Color fundus photograph, FOV: 45 degrees, 2212x1659:
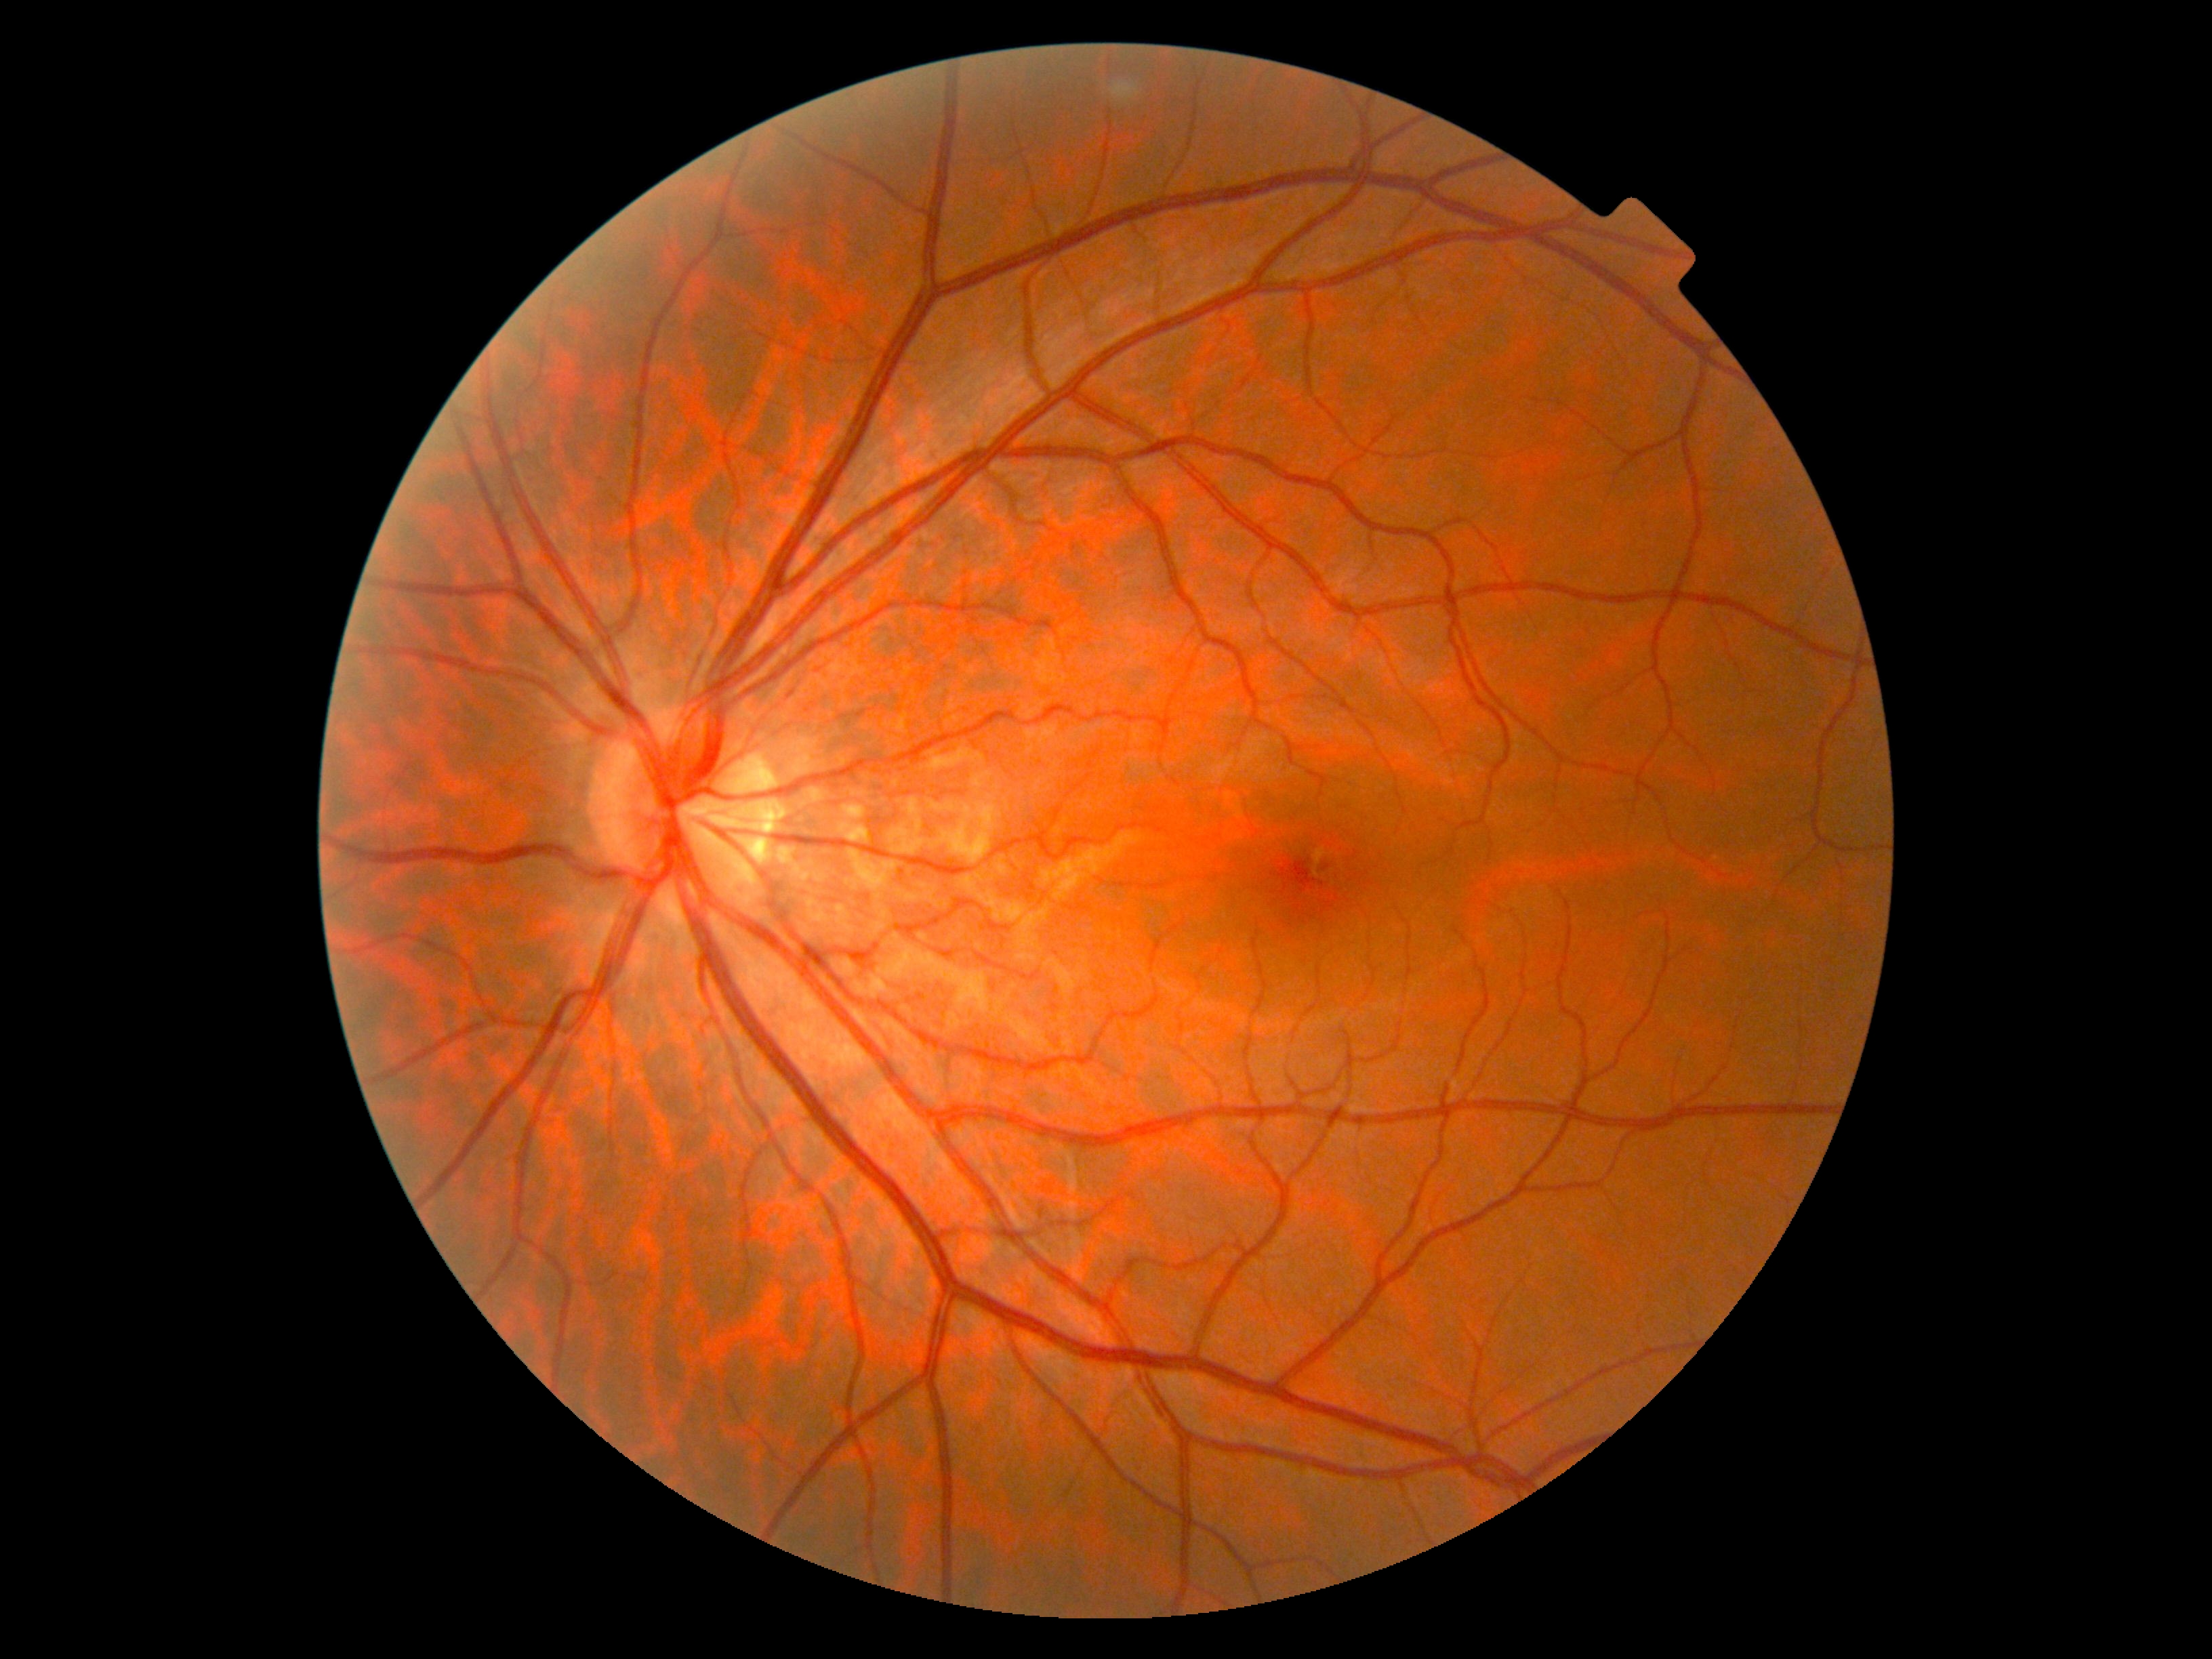

diabetic retinopathy (DR) = grade 0 (no apparent retinopathy).